45 degree fundus photograph:
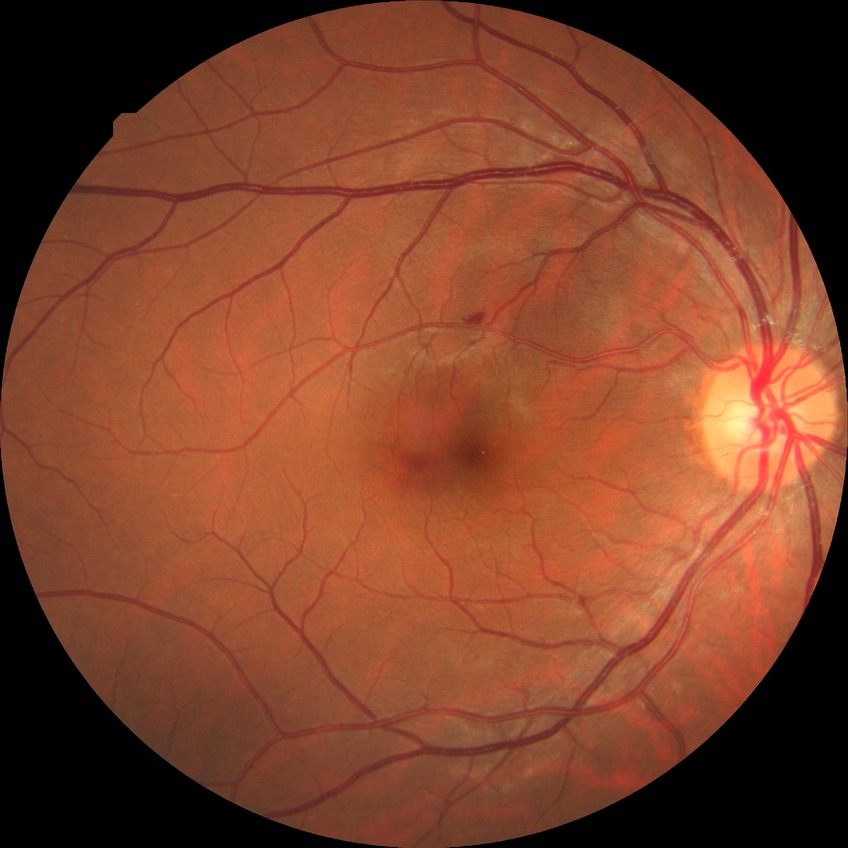 modified Davis classification = simple diabetic retinopathy.